Camera: Clarity RetCam 3 (130° FOV) · wide-field fundus photograph from neonatal ROP screening — 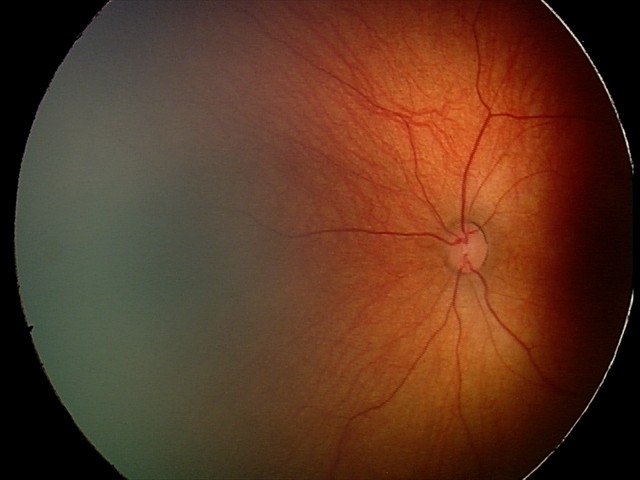 Screening series with retinal hemorrhages.